2212x1659px:
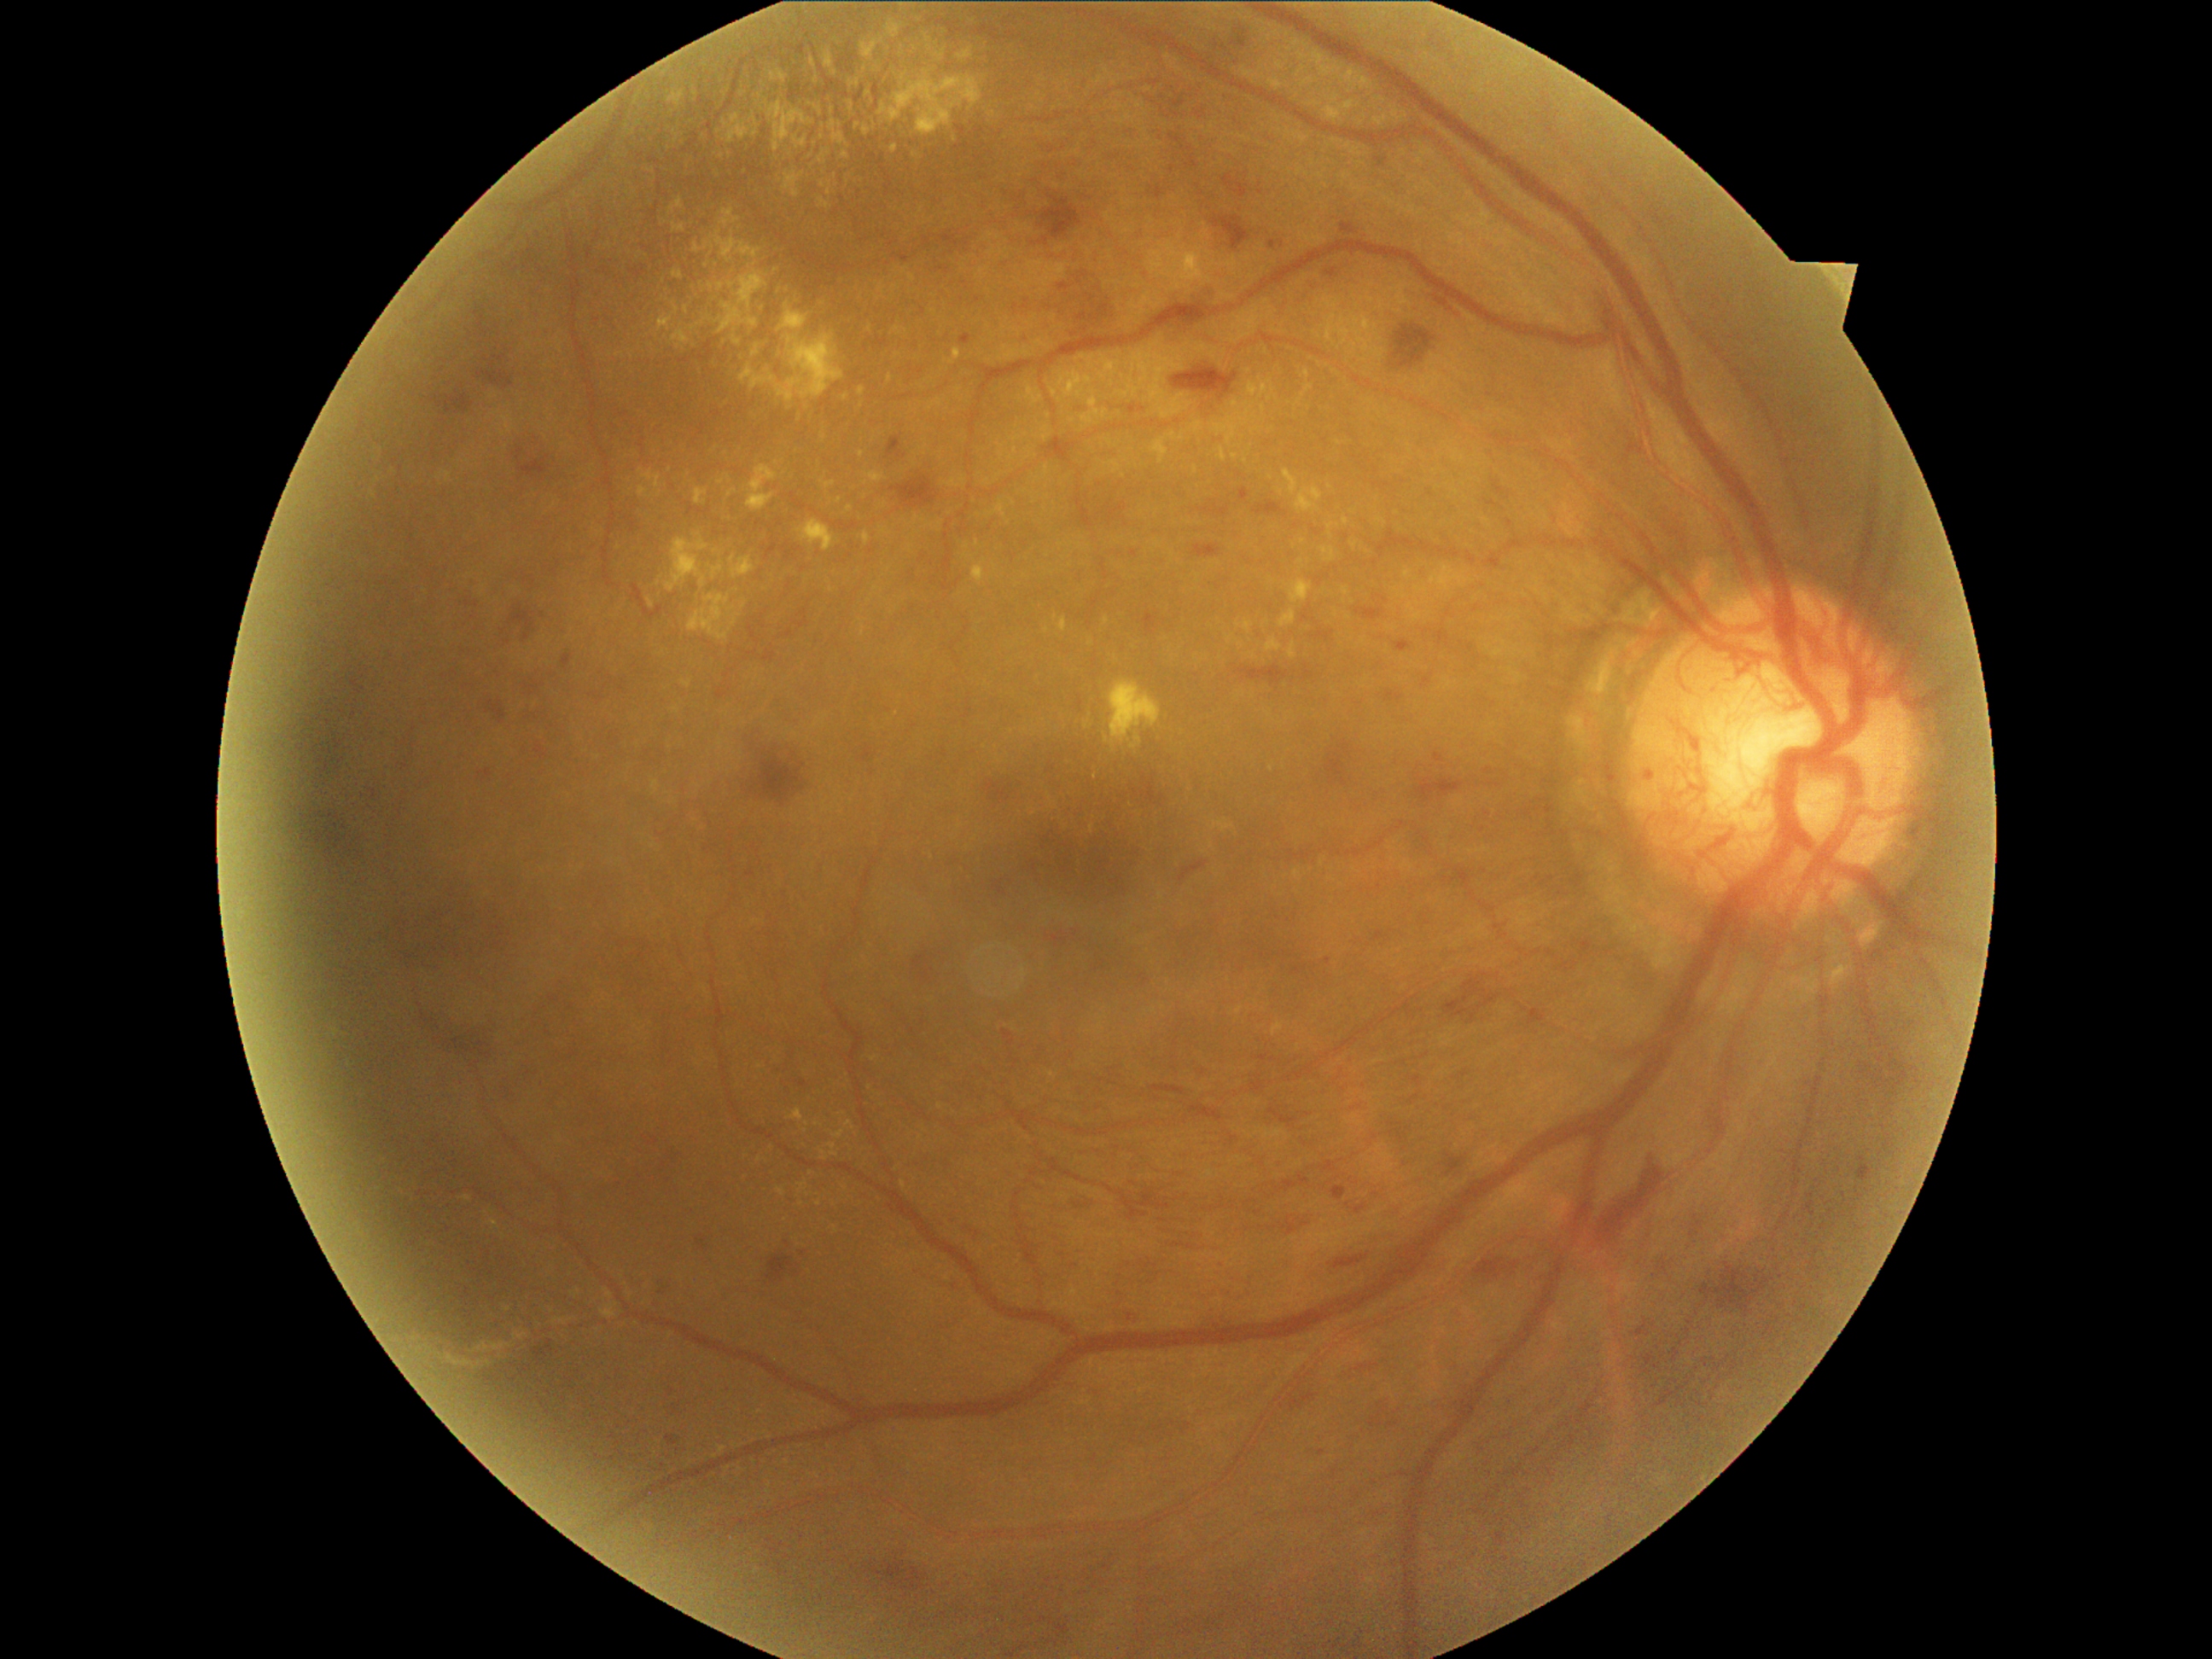 Diabetic retinopathy (DR): proliferative diabetic retinopathy (grade 4) — neovascularization and/or vitreous/pre-retinal hemorrhage; proliferative diabetic retinopathy
A subset of detected lesions:
* hemorrhages (HEs) (partial): box=[1223, 175, 1249, 197], box=[1141, 774, 1165, 806], box=[298, 731, 315, 752], box=[1284, 1175, 1310, 1192], box=[1213, 26, 1255, 73], box=[1172, 363, 1238, 402], box=[1358, 1365, 1380, 1373], box=[1356, 607, 1385, 620], box=[767, 1254, 800, 1284], box=[1486, 501, 1499, 508], box=[1506, 520, 1513, 528], box=[912, 953, 928, 970], box=[1237, 665, 1289, 687], box=[1151, 131, 1208, 197], box=[894, 253, 909, 264]
* HEs (small, approximate centers) near pt(334, 803)
* hard exudates (EXs) (partial): box=[1260, 405, 1266, 414], box=[675, 469, 690, 496], box=[892, 146, 899, 154], box=[1213, 417, 1238, 446], box=[793, 136, 808, 149], box=[554, 1318, 569, 1325], box=[1322, 323, 1334, 330], box=[665, 533, 709, 593], box=[1095, 407, 1105, 421], box=[1375, 115, 1390, 127], box=[644, 470, 661, 489], box=[974, 564, 986, 585], box=[1044, 428, 1051, 441], box=[812, 59, 817, 71]
* EXs (small, approximate centers) near pt(993, 115), pt(835, 1229), pt(759, 1066), pt(815, 145), pt(734, 622), pt(1310, 388)